Color fundus image, 2048x1536px — 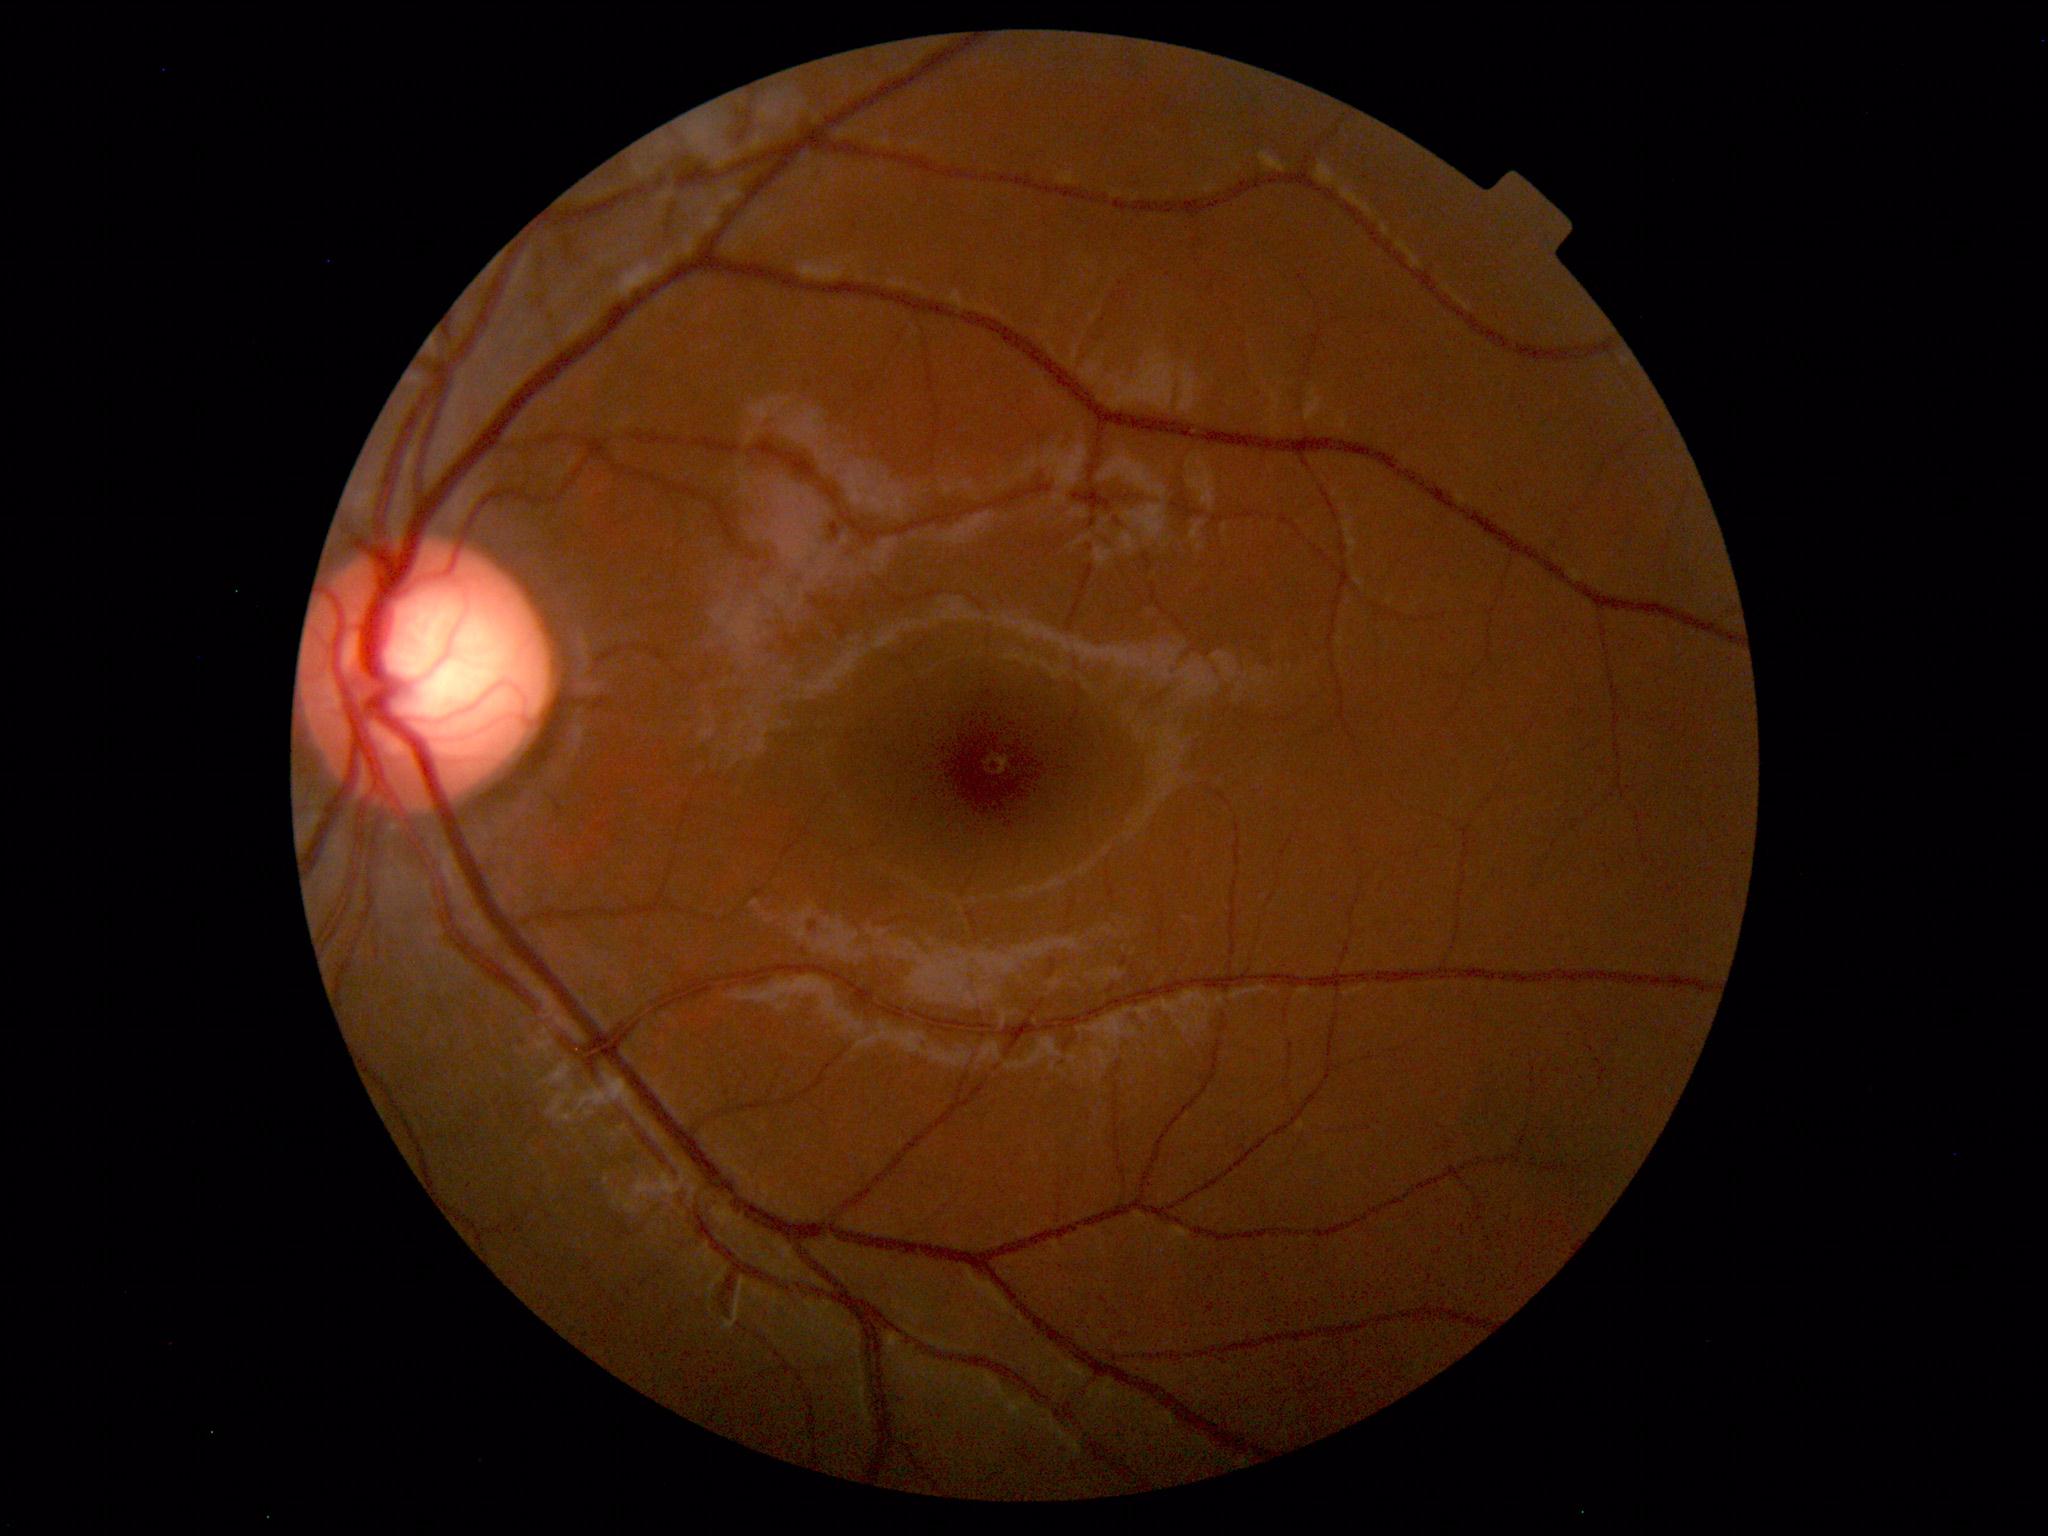

Diagnosis: normal.